DR severity per modified Davis staging:
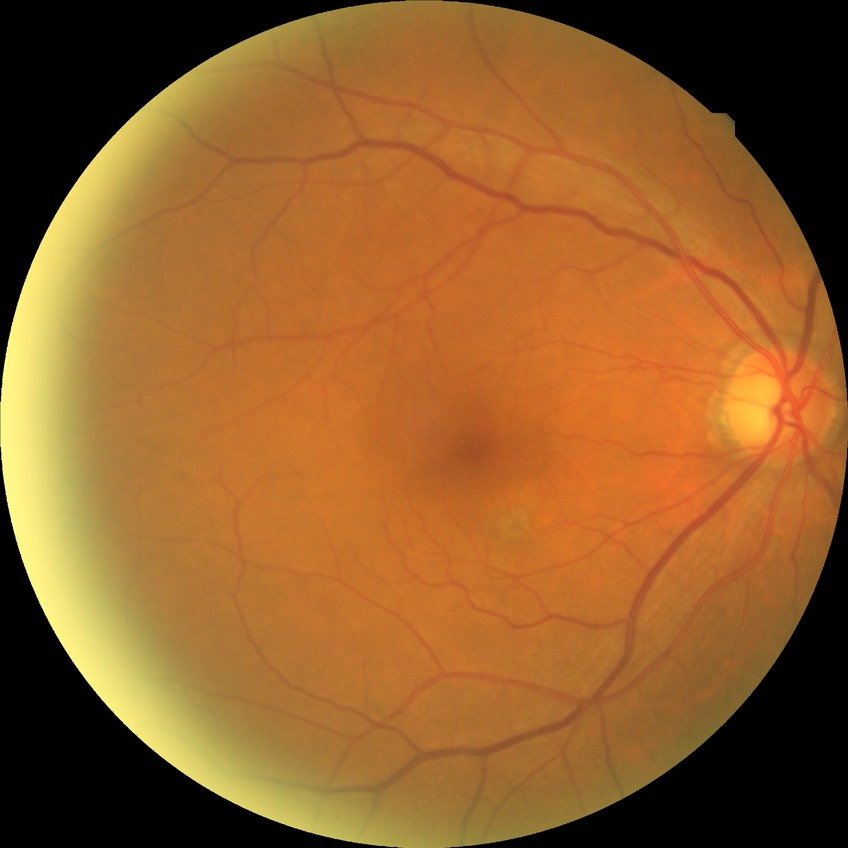

Diabetic retinopathy (DR): no diabetic retinopathy (NDR).